848 x 848 pixels · no pharmacologic dilation — 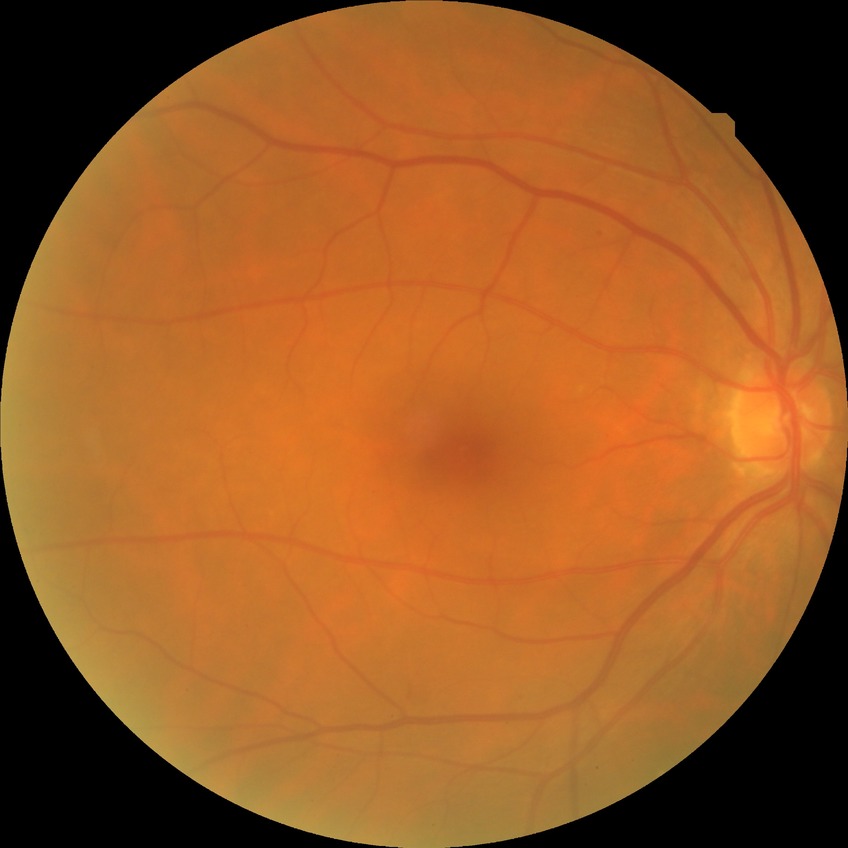
Diabetic retinopathy (DR): simple diabetic retinopathy (SDR).